848x848. Davis DR grading. Nonmydriatic
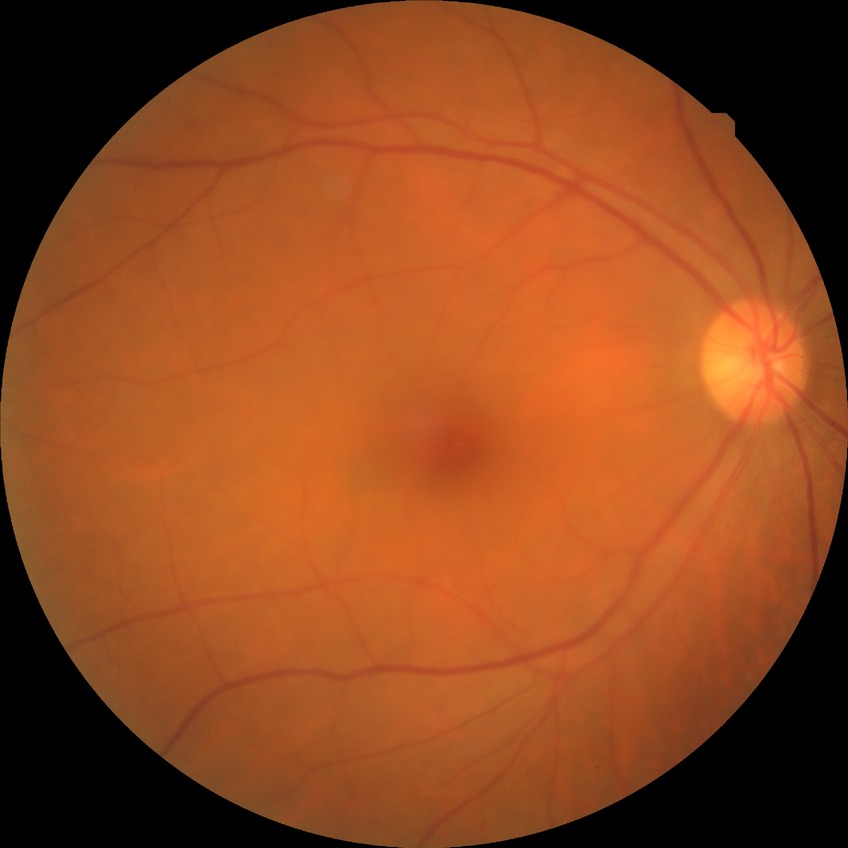
Modified Davis grading: no diabetic retinopathy.